45° field of view · 2352 by 1568 pixels
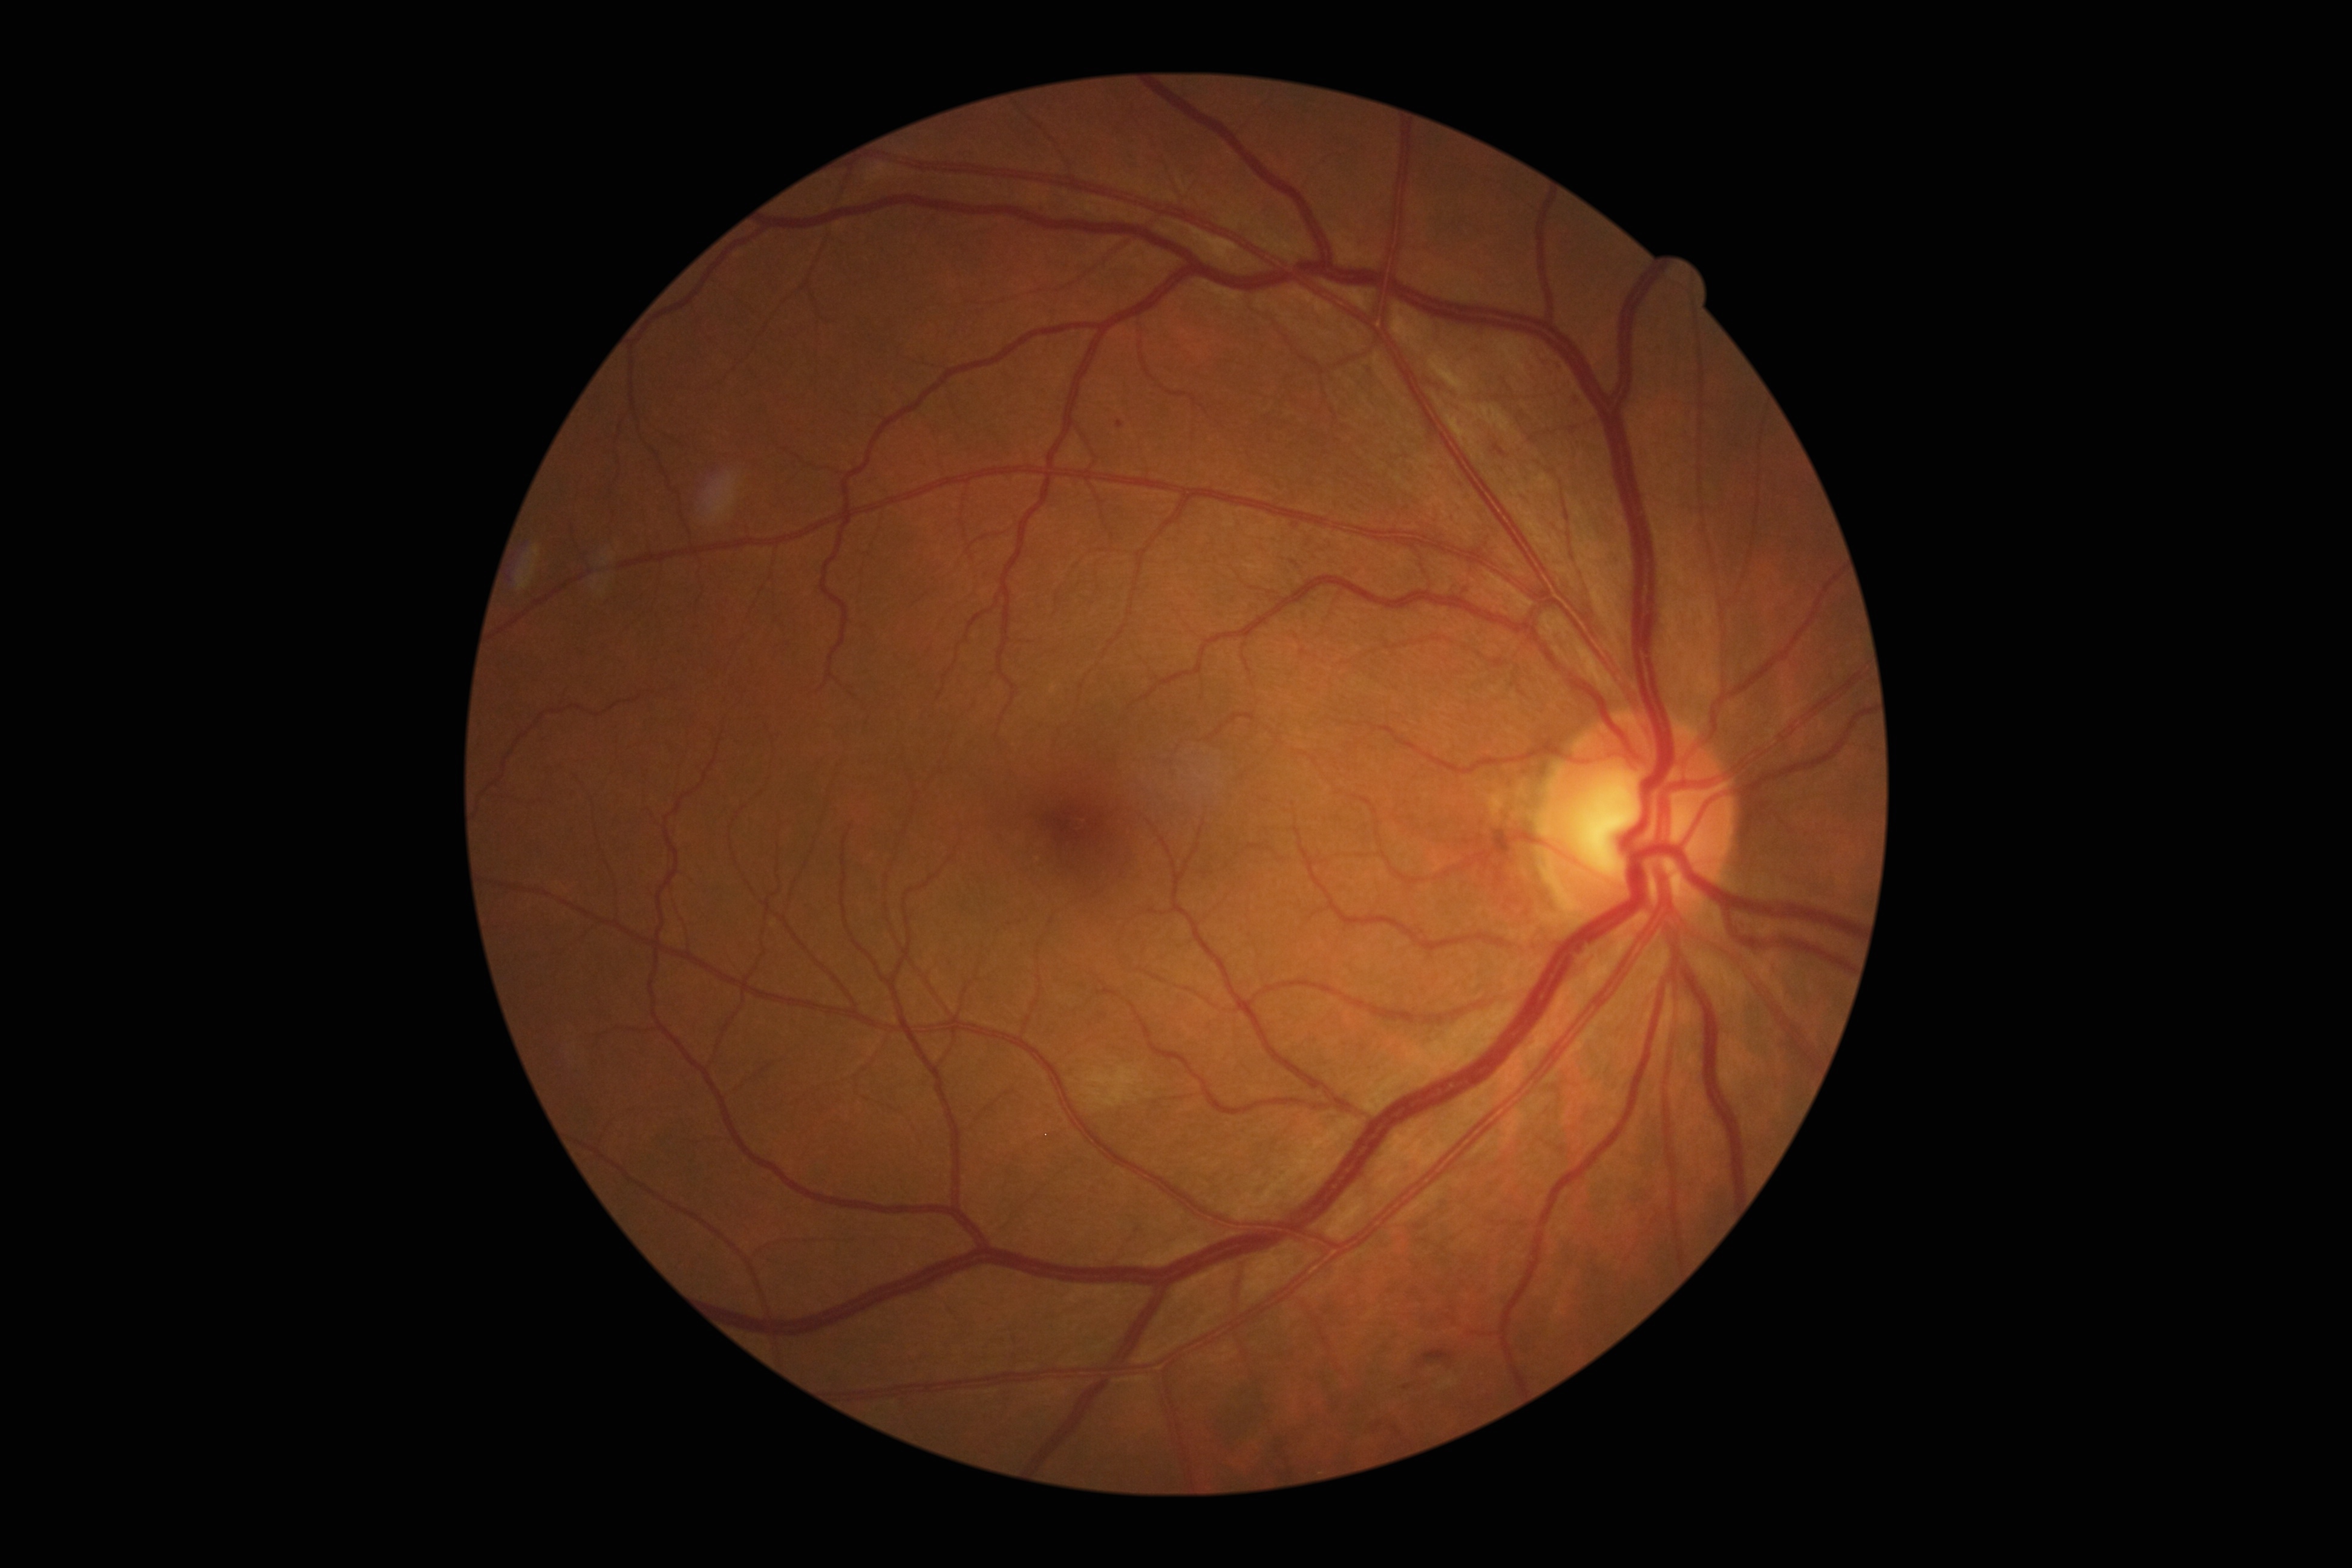 {"dr_category": "non-proliferative diabetic retinopathy", "dr_grade": "moderate NPDR (grade 2) — more than just microaneurysms but less than severe NPDR"}